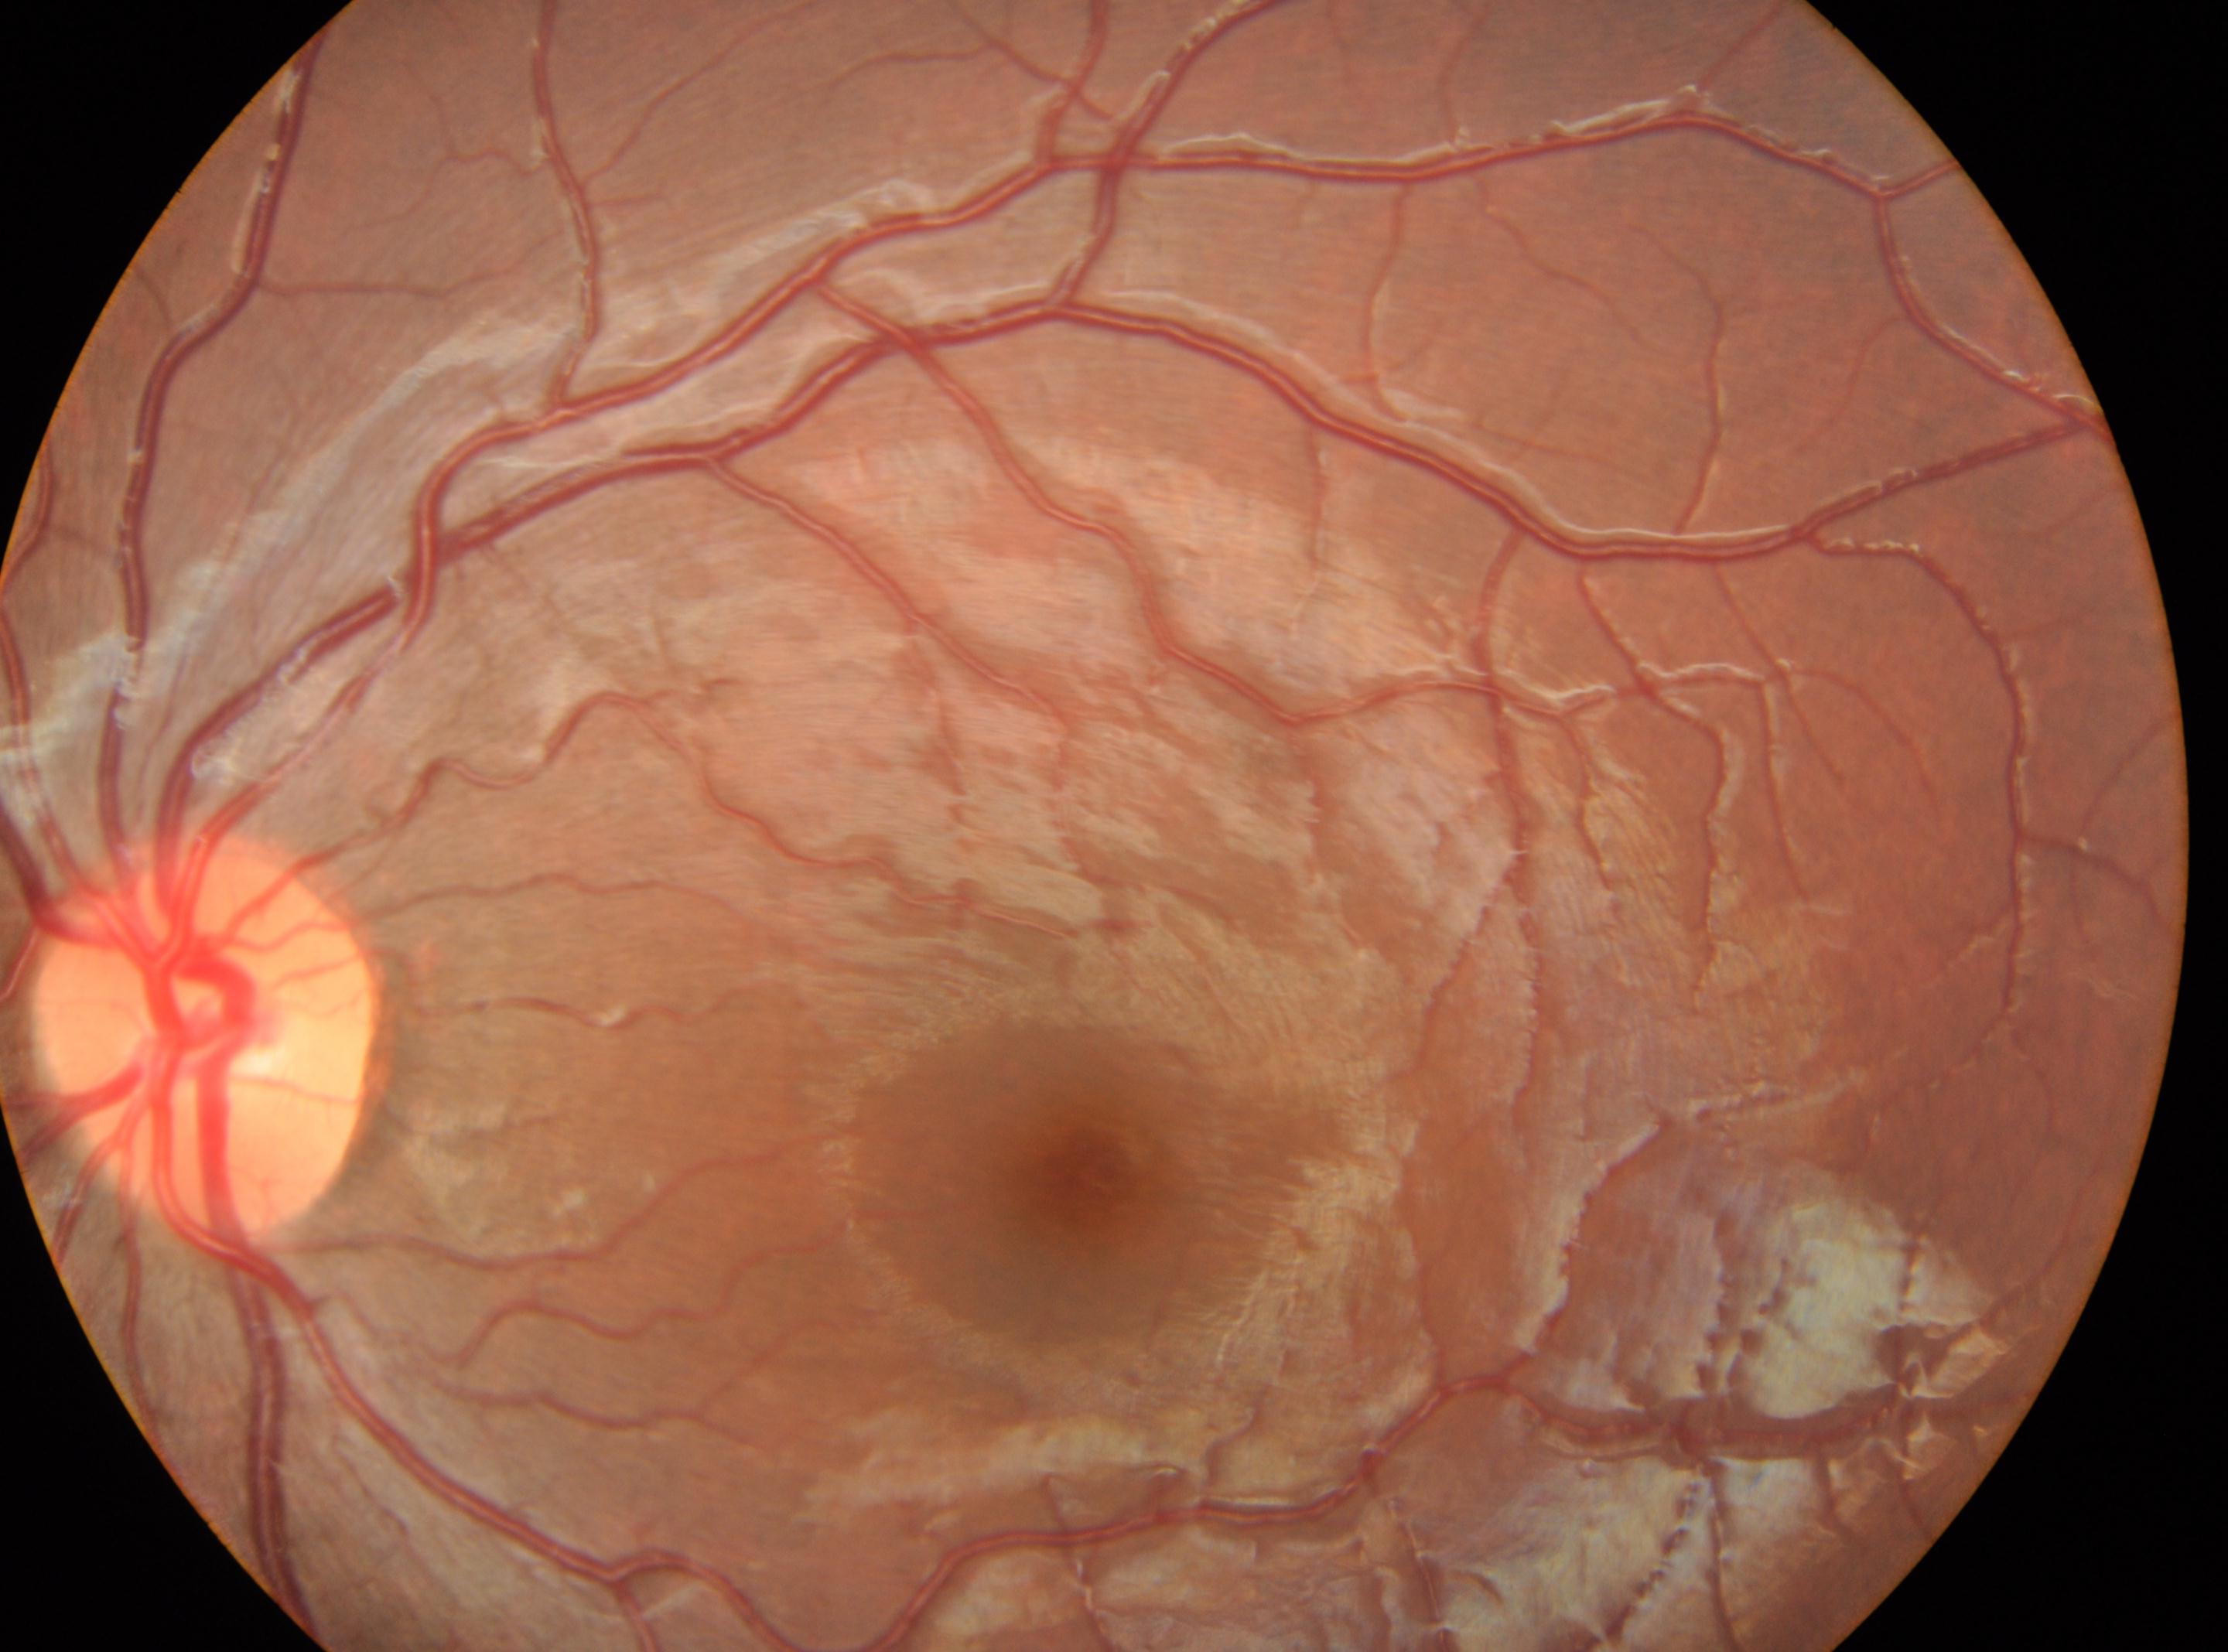

DR severity: grade 0 (no apparent retinopathy).
Optic disc center located at 208, 1032.
Eye: left eye.
The fovea centralis is at 1102, 1174.